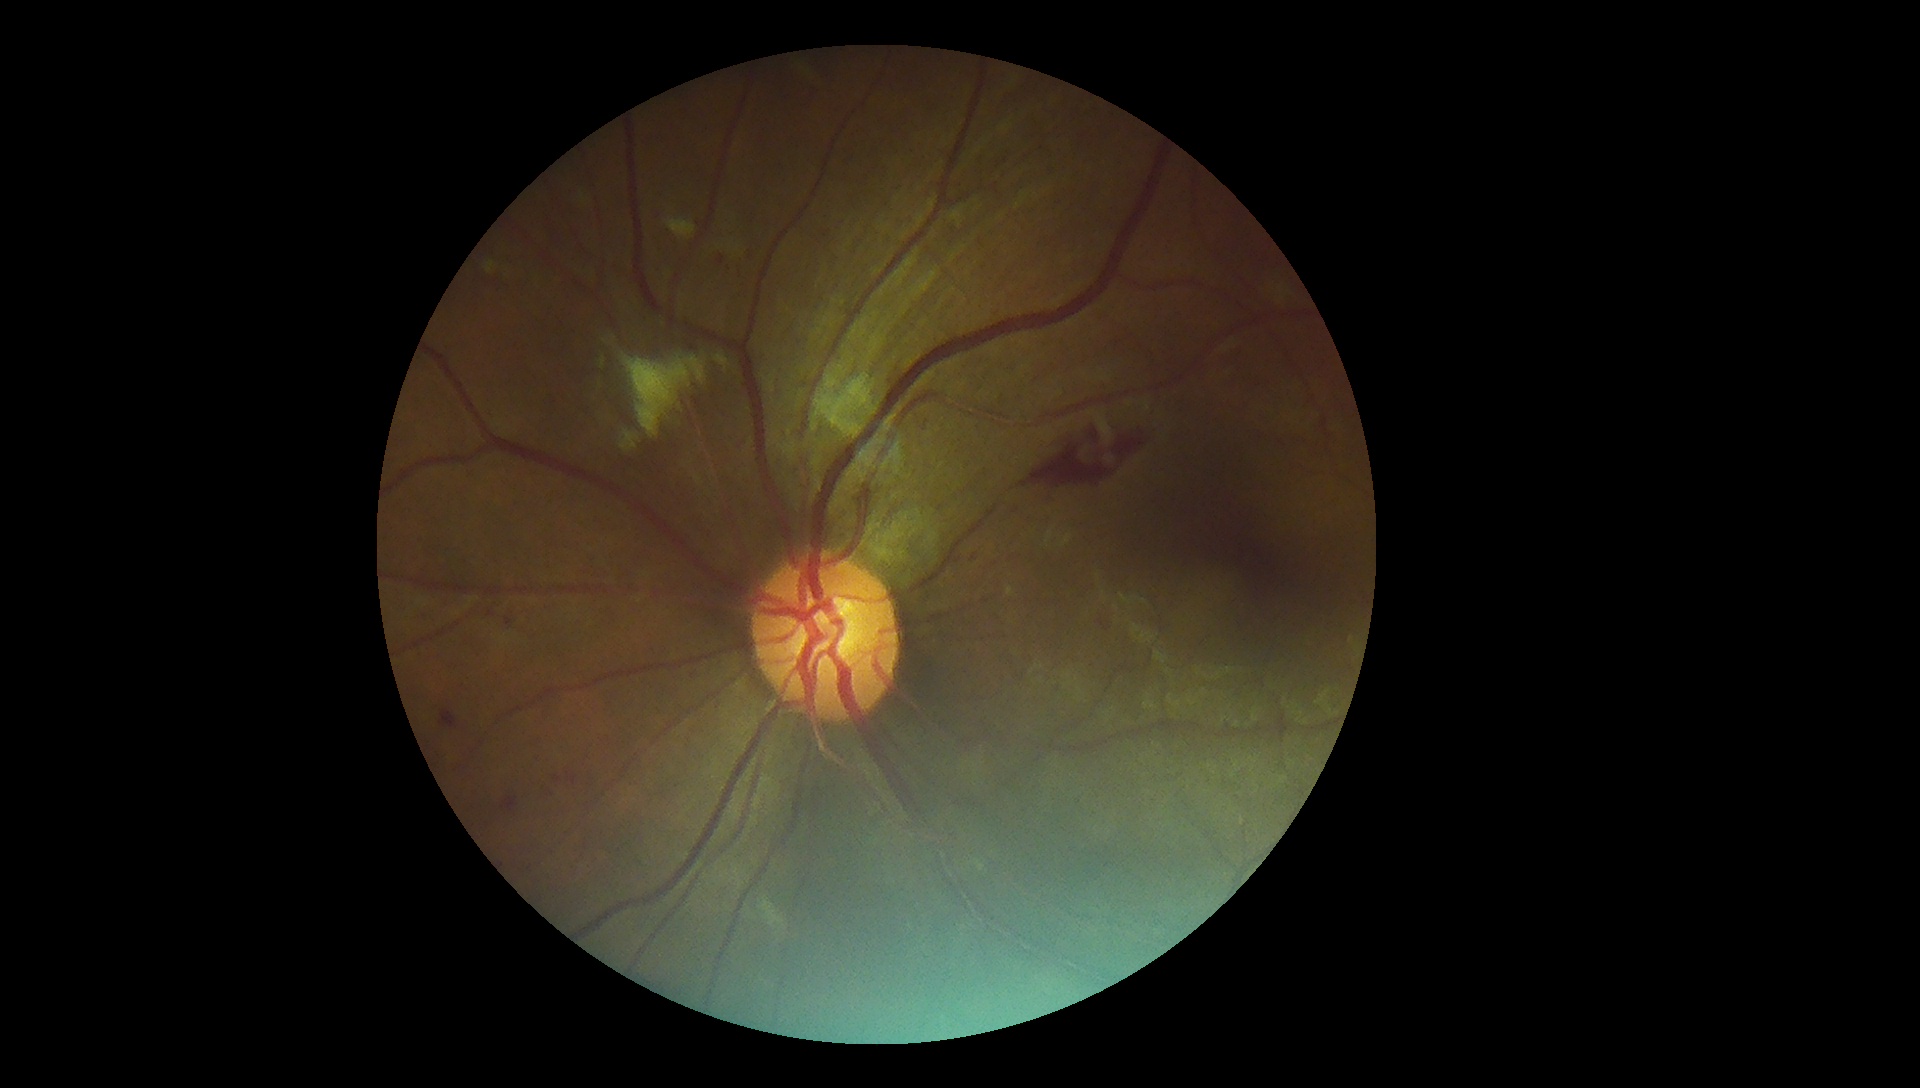 Diabetic retinopathy grade is 2.